Camera: Nidek AFC-330 · fundus photo.
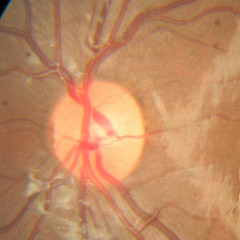
Impression = no signs of glaucoma.